Posterior pole color fundus photograph. NIDEK AFC-230 fundus camera. 45-degree field of view. 848 by 848 pixels
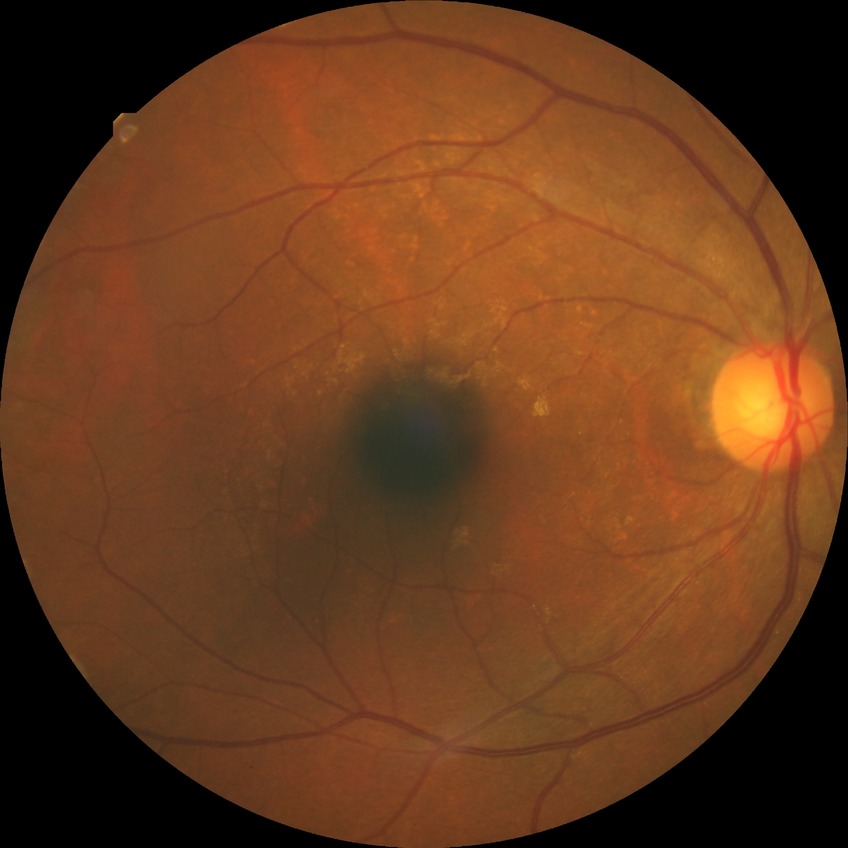
davis_grade: NDR (no diabetic retinopathy)